45 degree fundus photograph, nonmydriatic fundus photograph — 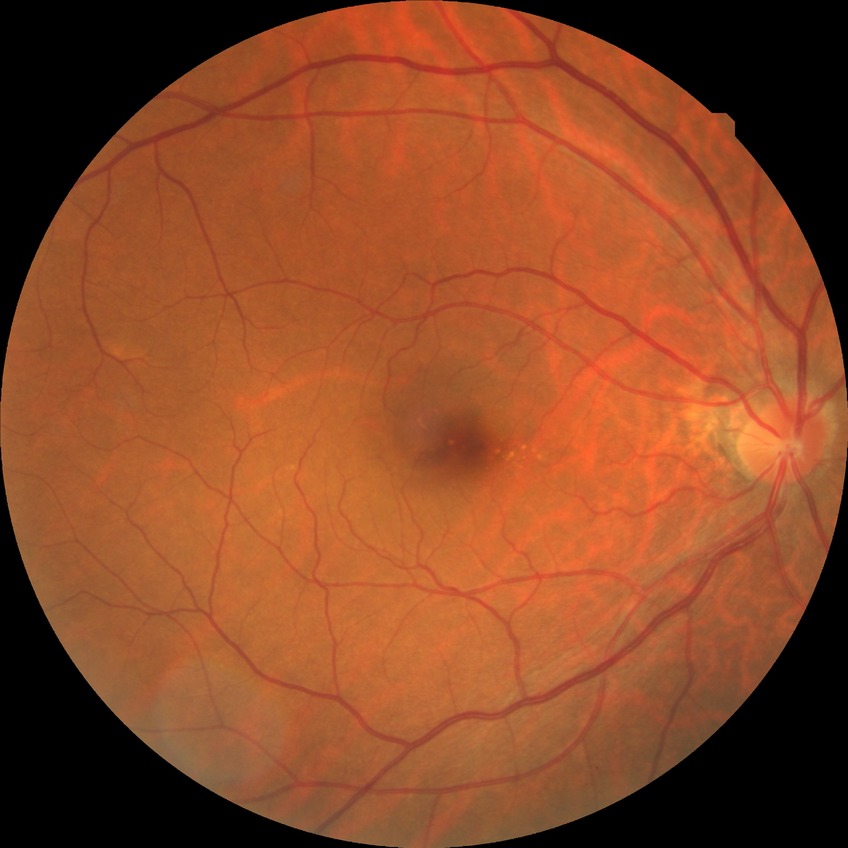

Diabetic retinopathy (DR) is NDR (no diabetic retinopathy).